45 degree fundus photograph
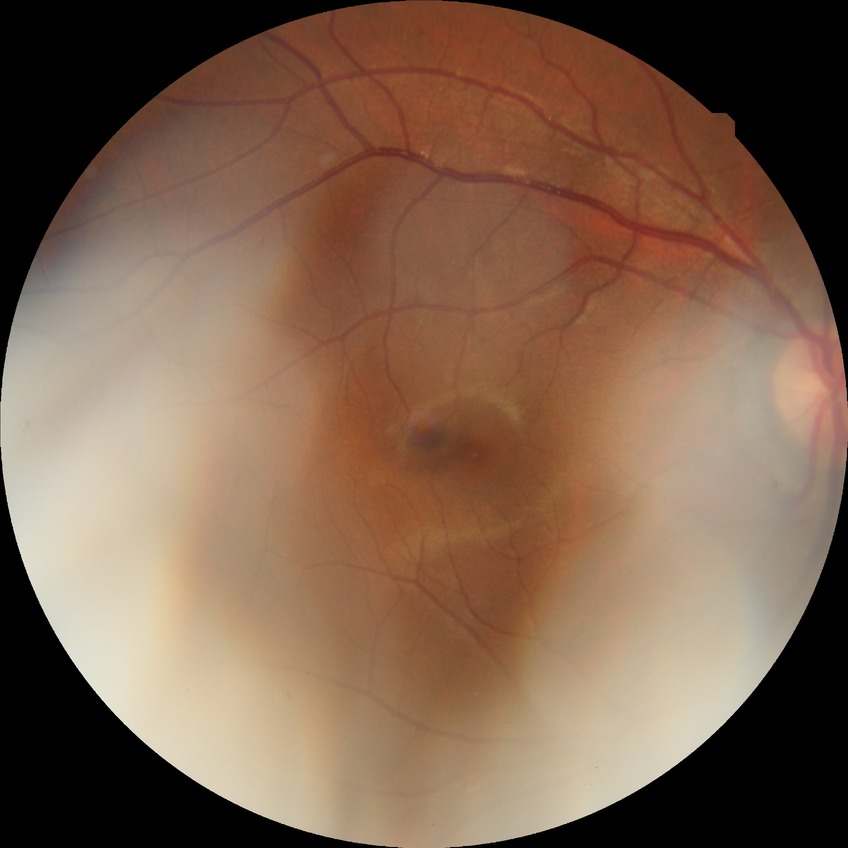 diabetic retinopathy (DR) = NDR (no diabetic retinopathy).